50° field of view, mydriatic (tropicamide phenylephrine 1.0%) — 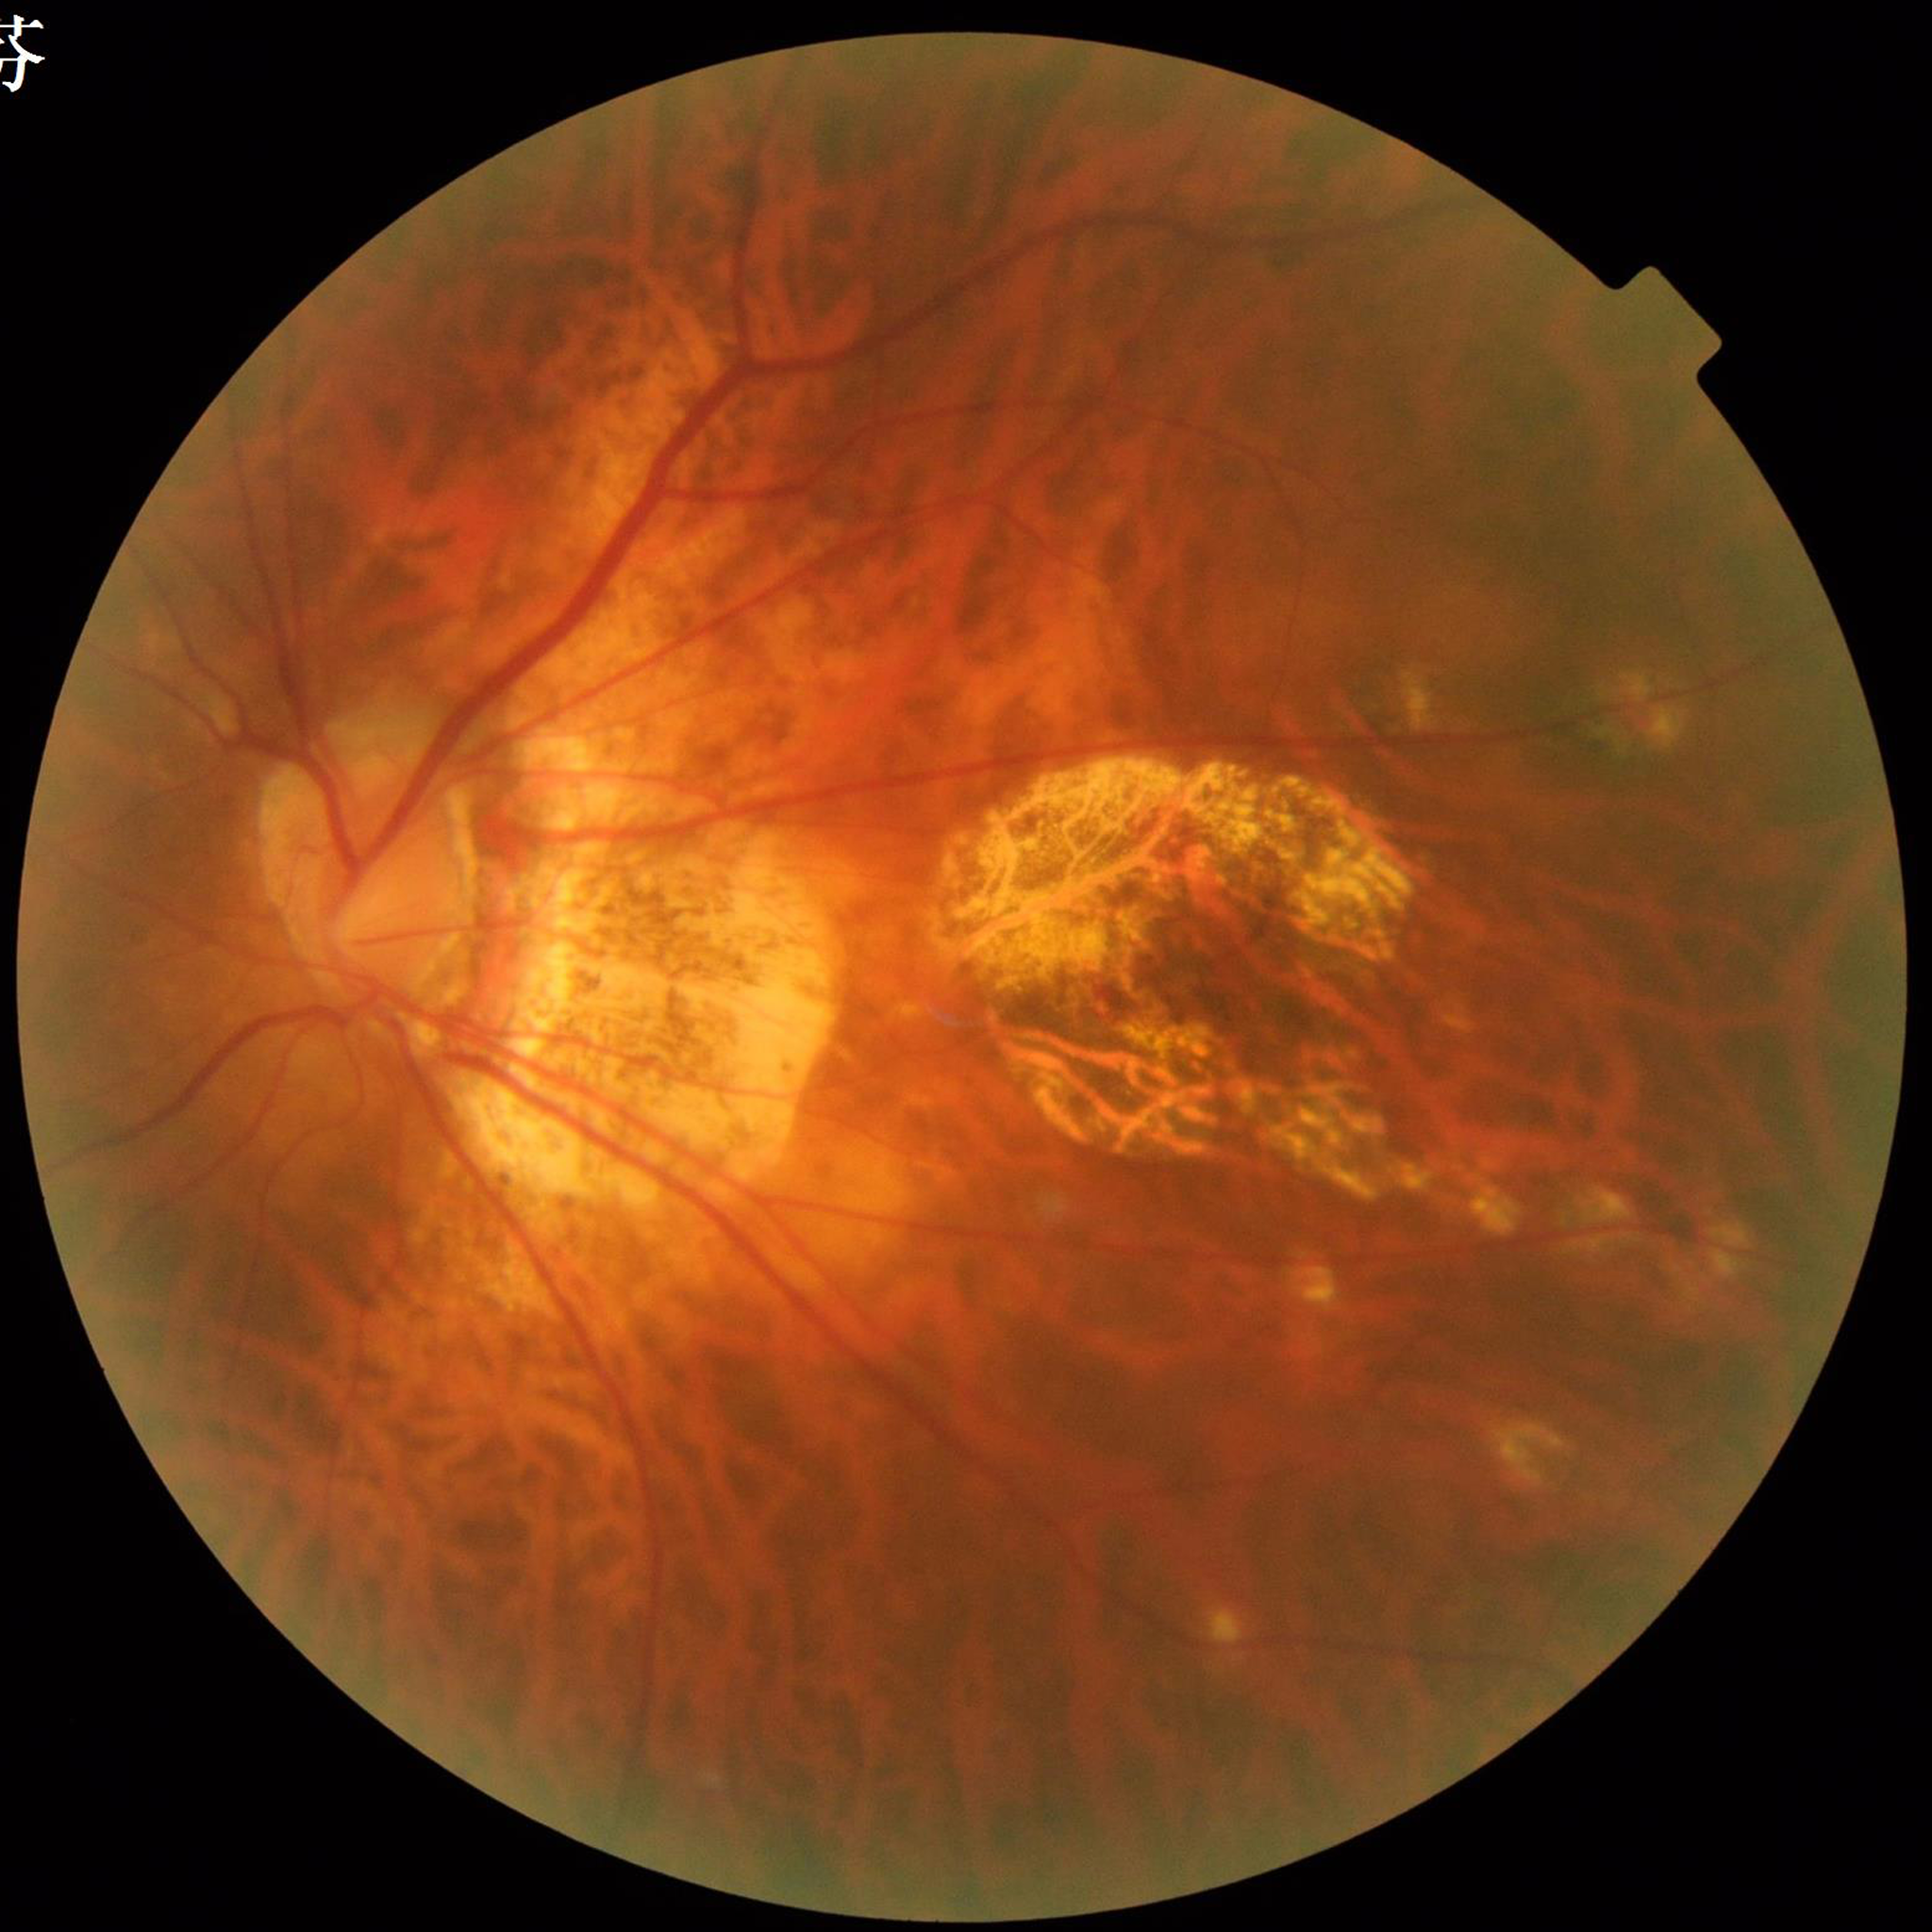
Eye affected by AMD.